Camera: NIDEK AFC-230 · graded on the modified Davis scale:
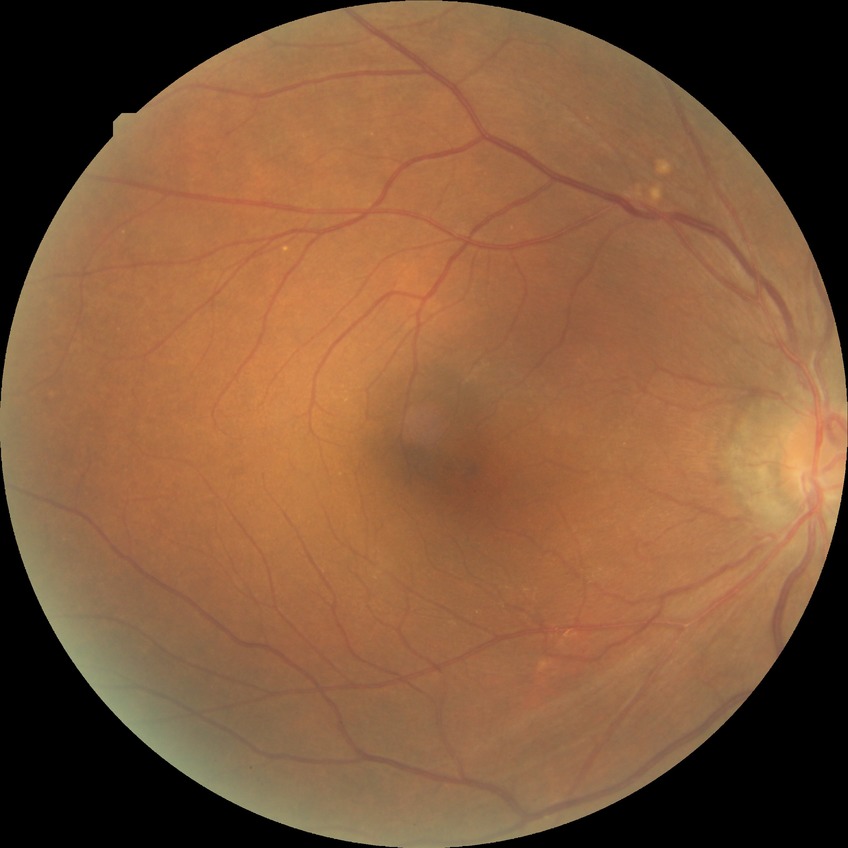 Davis grading: no diabetic retinopathy.